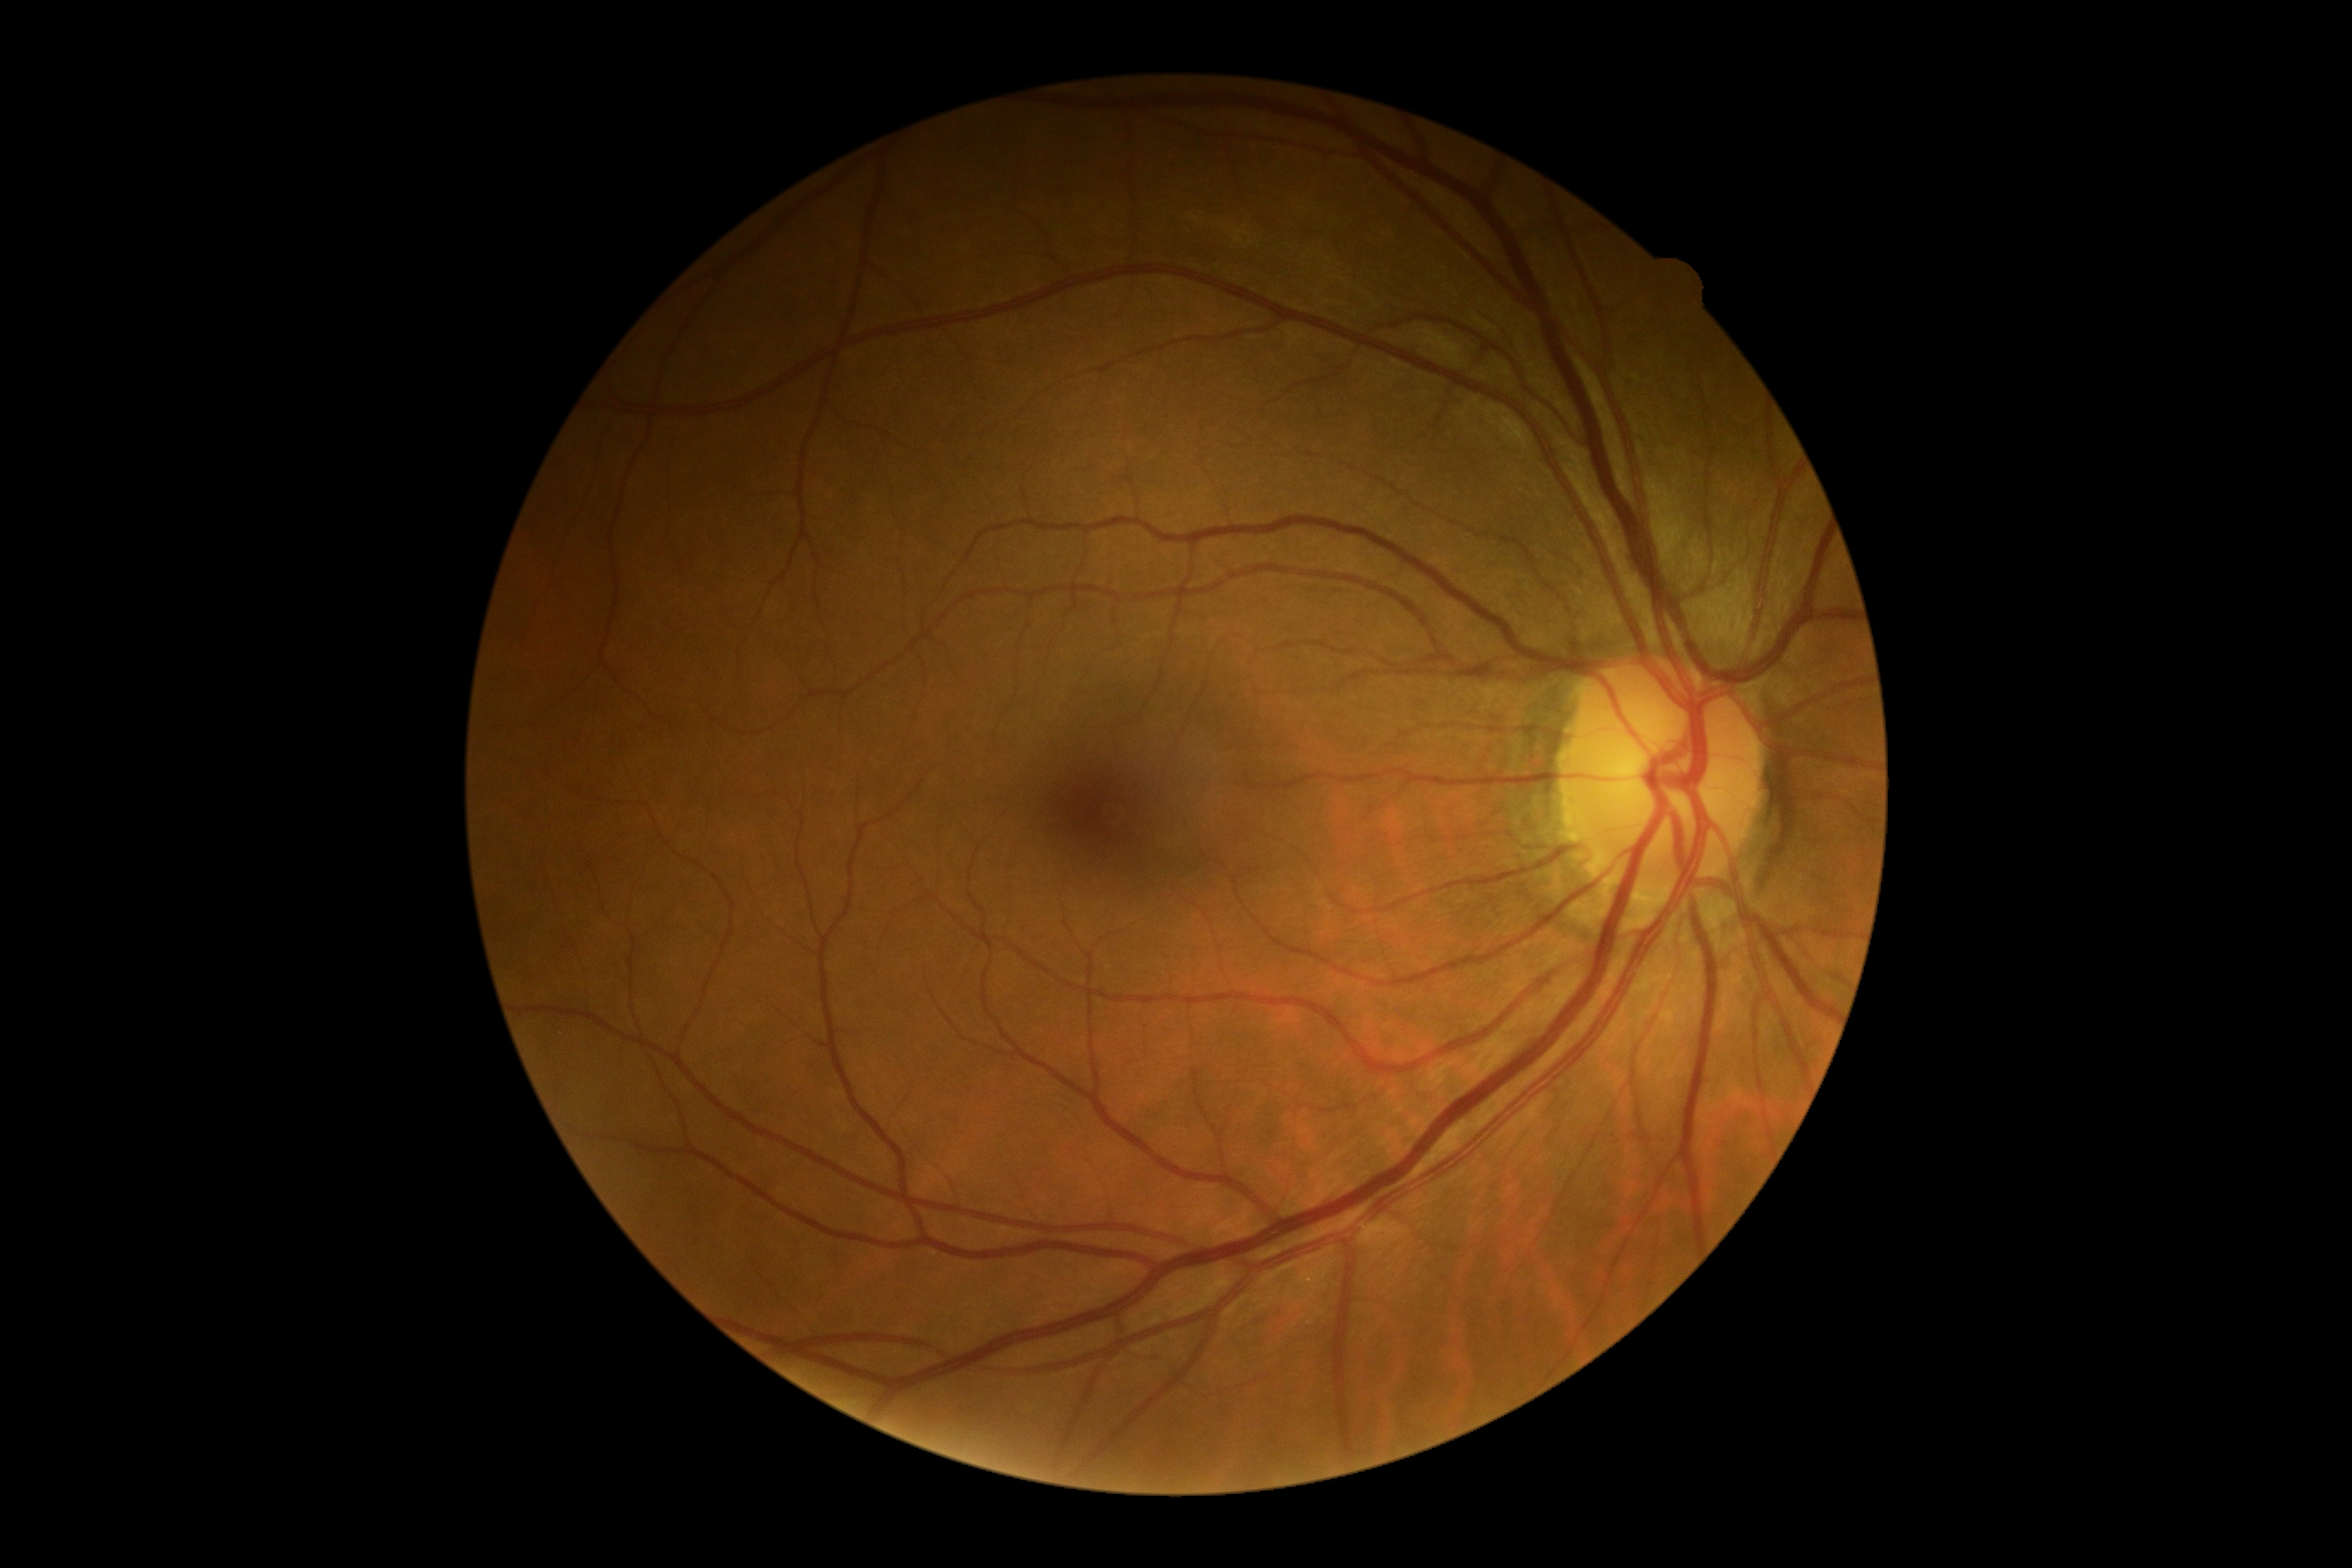
Diabetic retinopathy grade: no apparent diabetic retinopathy (0) — no visible signs of diabetic retinopathy.